Captured with the Natus RetCam Envision (130° field of view) · RetCam wide-field infant fundus image:
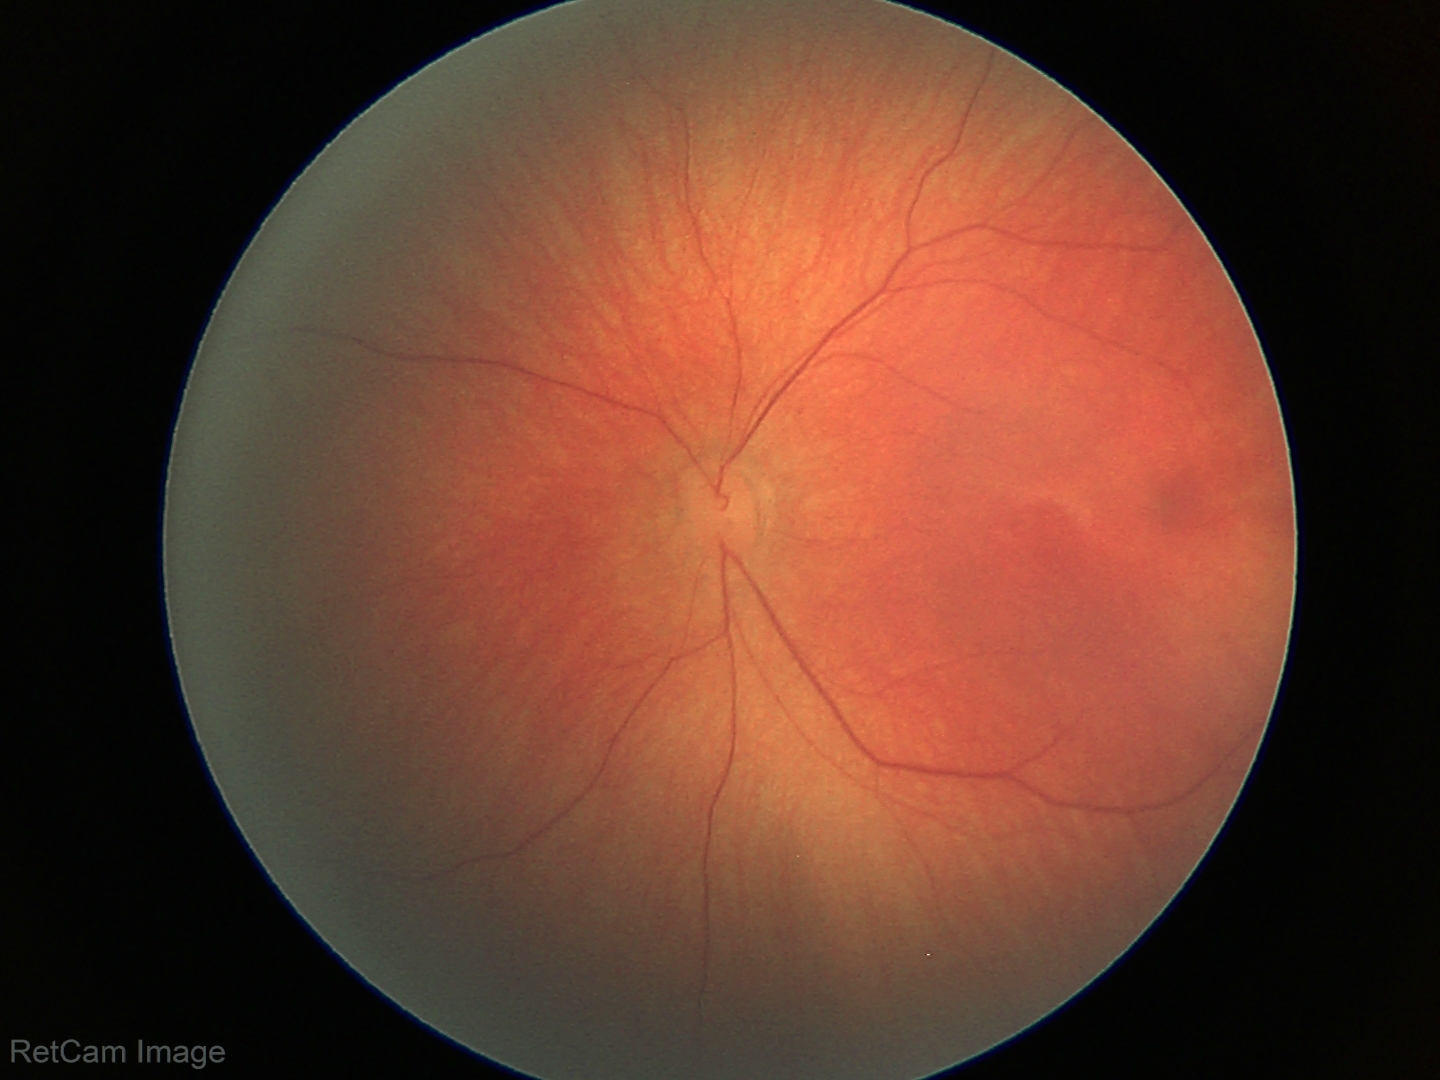 Screening examination with no abnormal retinal findings.